45° field of view
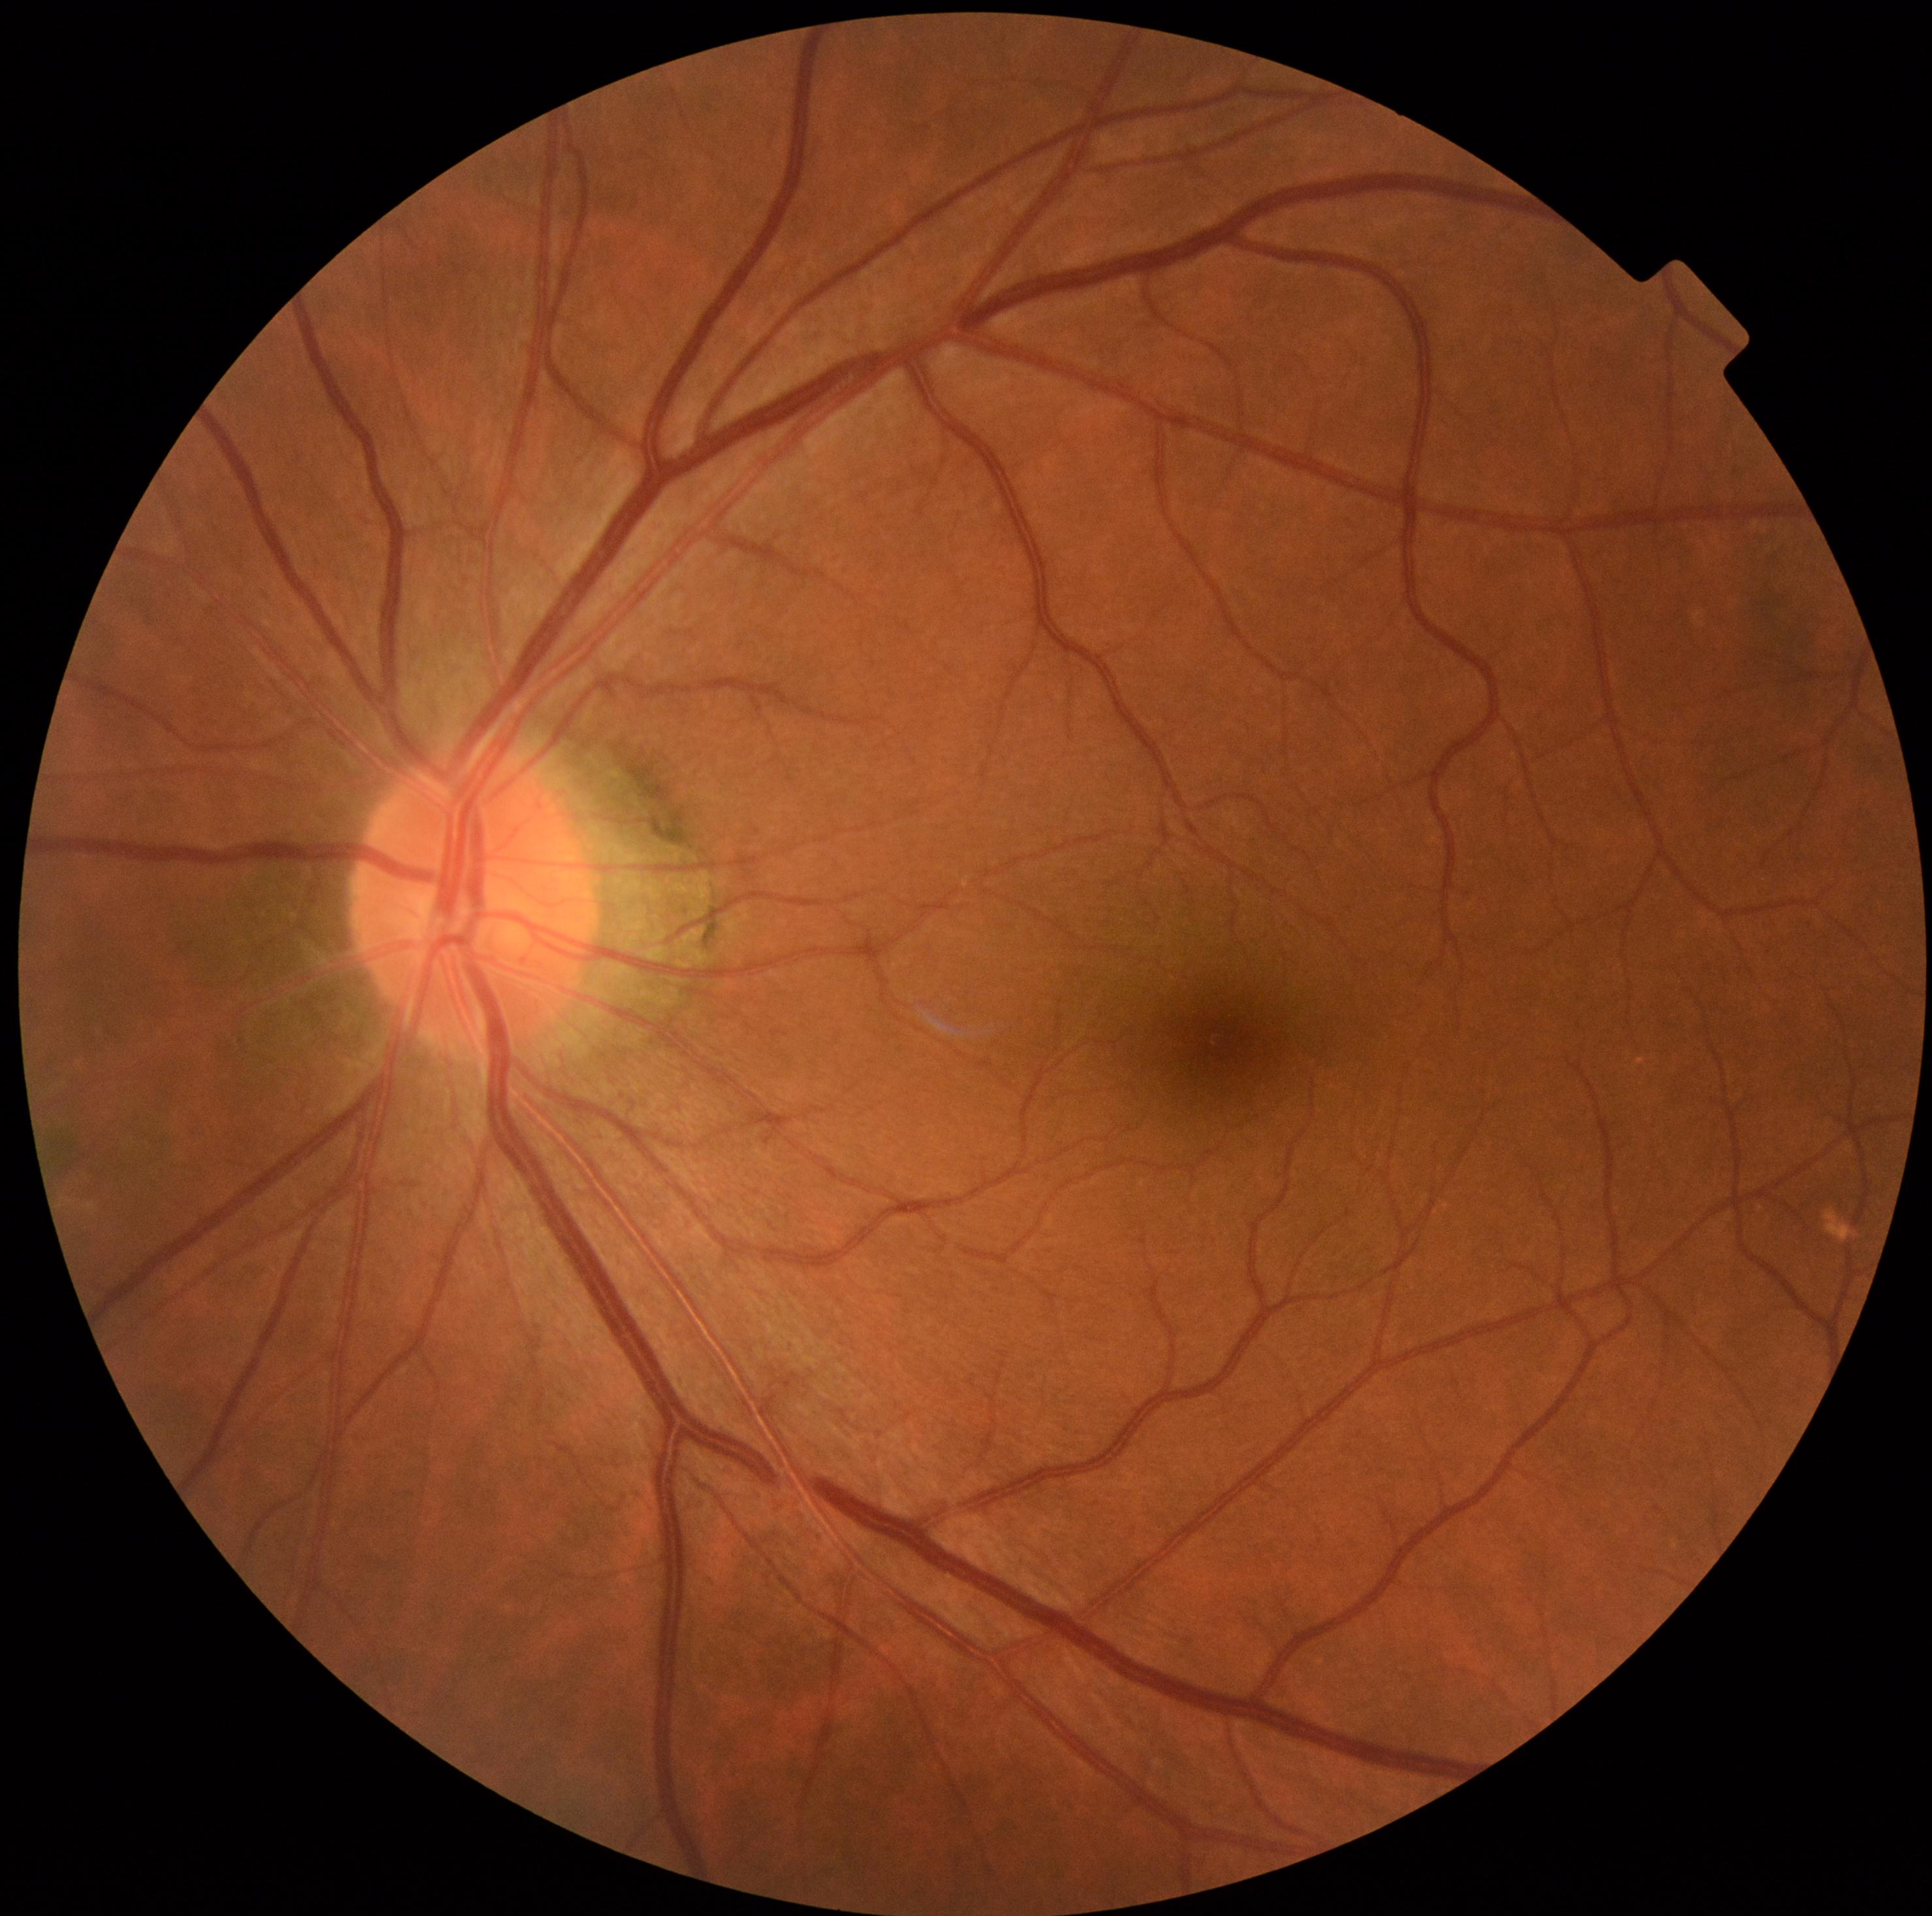 retinopathy=grade 0 (no apparent retinopathy).